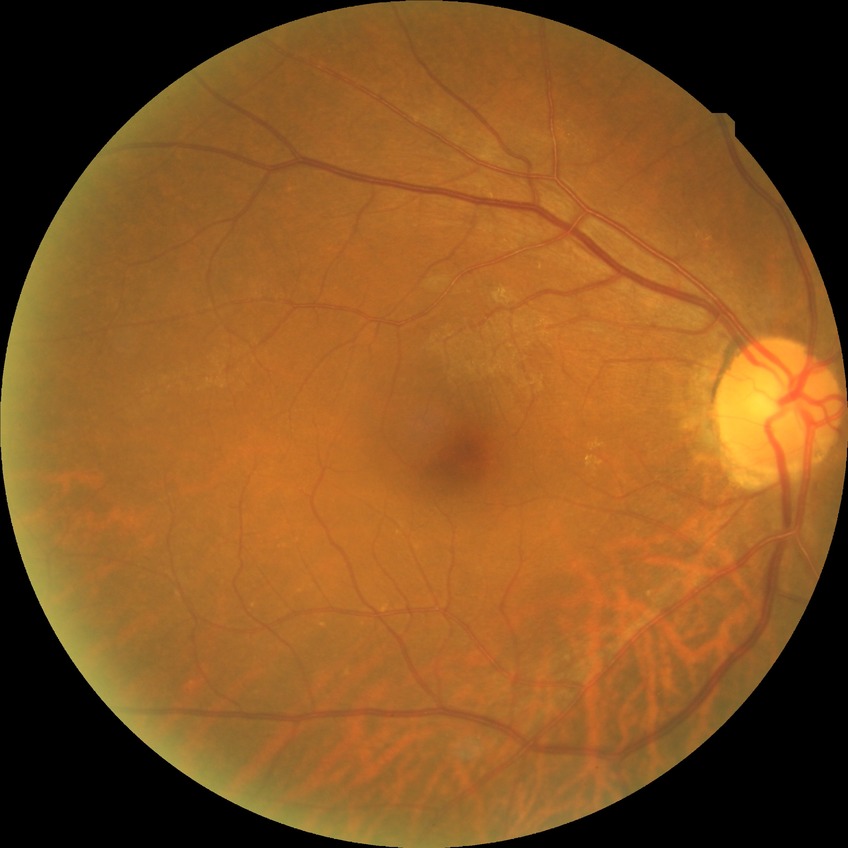

No diabetic retinal disease findings. Davis DR grade is NDR.